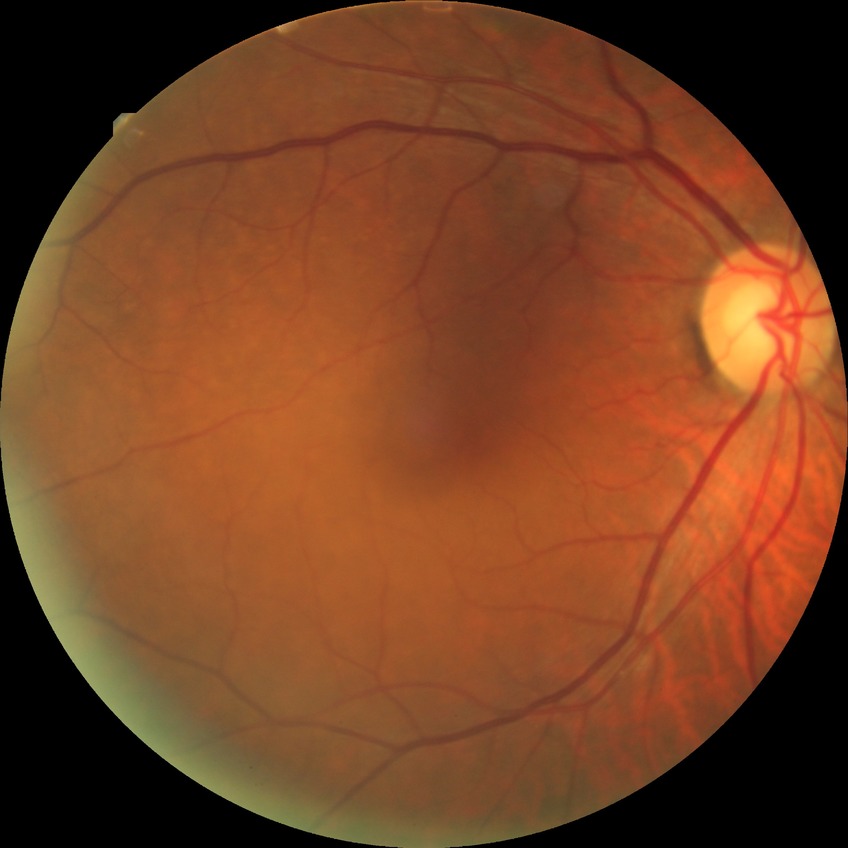
Diabetic retinopathy (DR): no diabetic retinopathy (NDR).